FOV: 45 degrees. Davis DR grading:
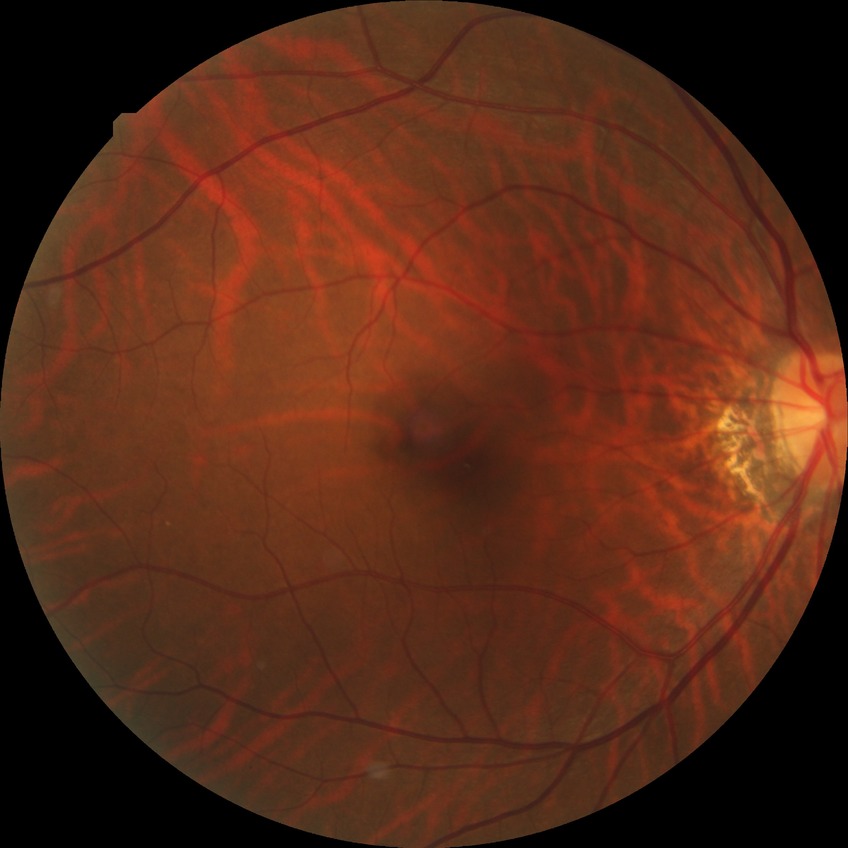 Davis grading: no diabetic retinopathy.